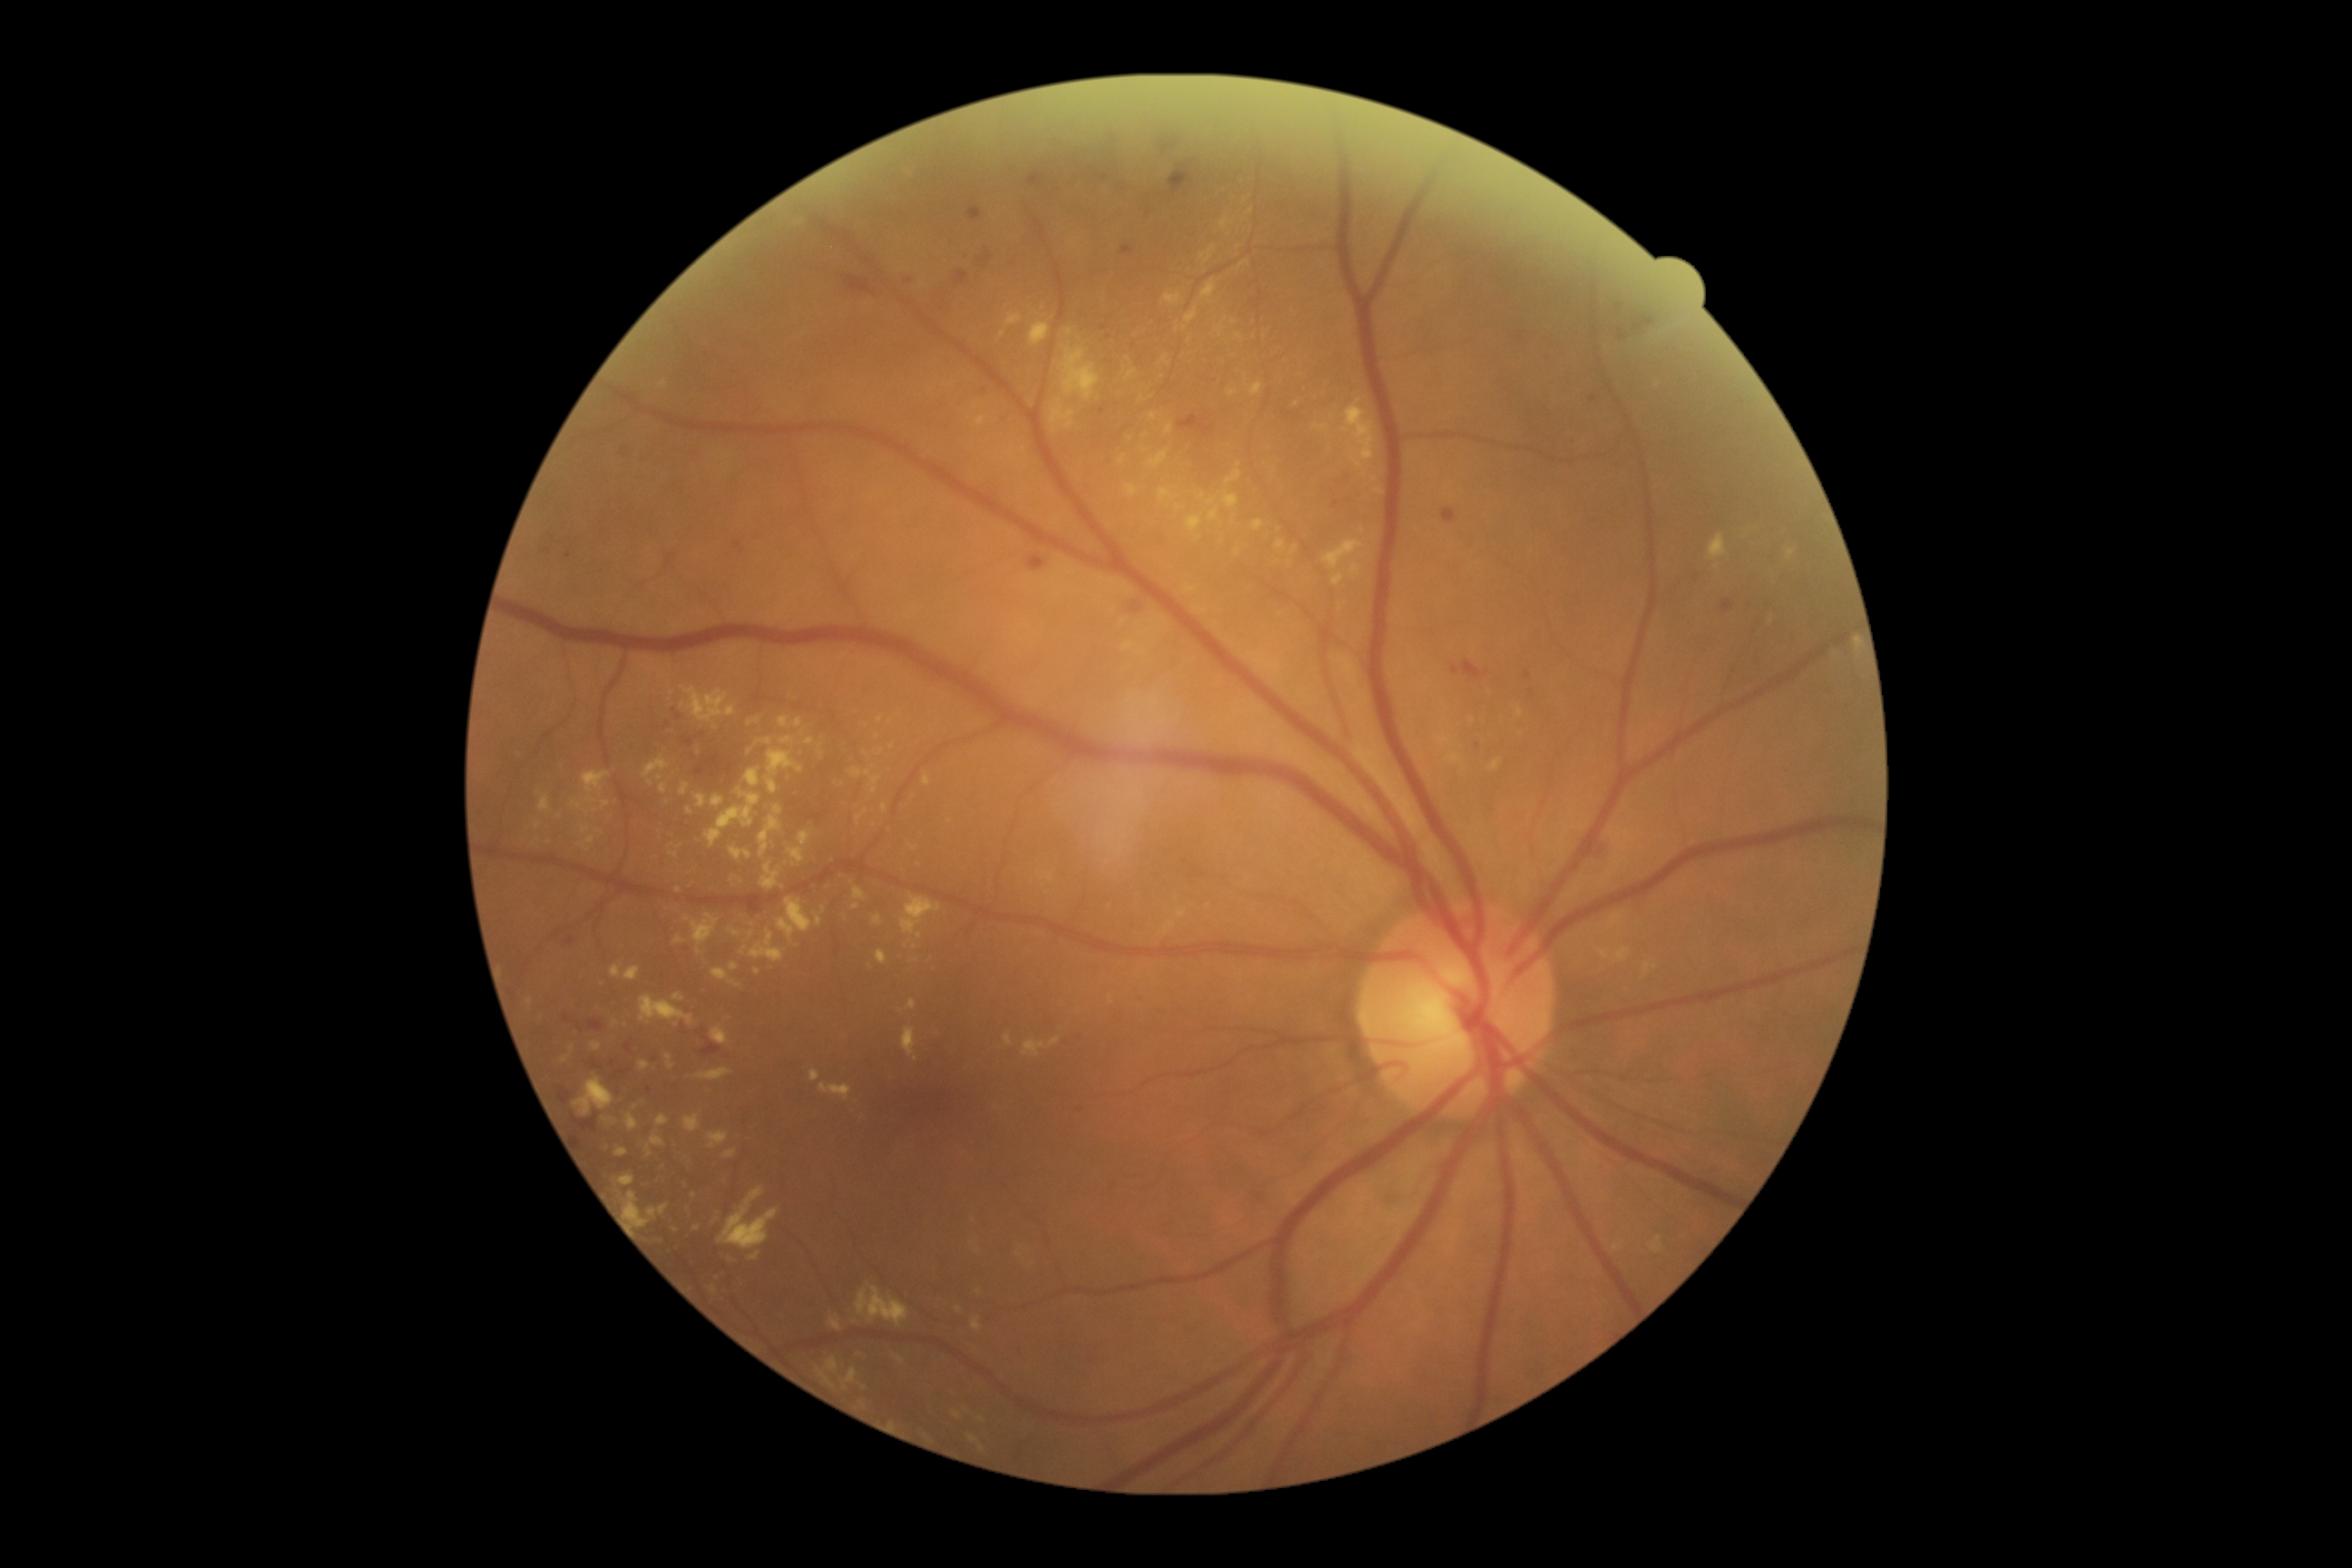 Diabetic retinopathy (DR) is moderate non-proliferative diabetic retinopathy (grade 2); non-proliferative diabetic retinopathy. Hard exudates (EXs) are present, including at bbox=[870, 778, 881, 794]; bbox=[1122, 642, 1133, 651]; bbox=[611, 965, 623, 979]; bbox=[582, 770, 611, 794]; bbox=[672, 994, 685, 1003]; bbox=[1614, 914, 1623, 923]; bbox=[730, 963, 738, 972]; bbox=[765, 750, 805, 794]; bbox=[680, 783, 691, 796]; bbox=[1066, 329, 1073, 337]; bbox=[710, 1028, 730, 1046]; bbox=[852, 887, 867, 903]. Additional small EXs near point(825, 911); point(651, 784); point(1178, 508); point(920, 935); point(1771, 621); point(915, 948).